Fundus photo · 1932x1932px · 45° field of view: 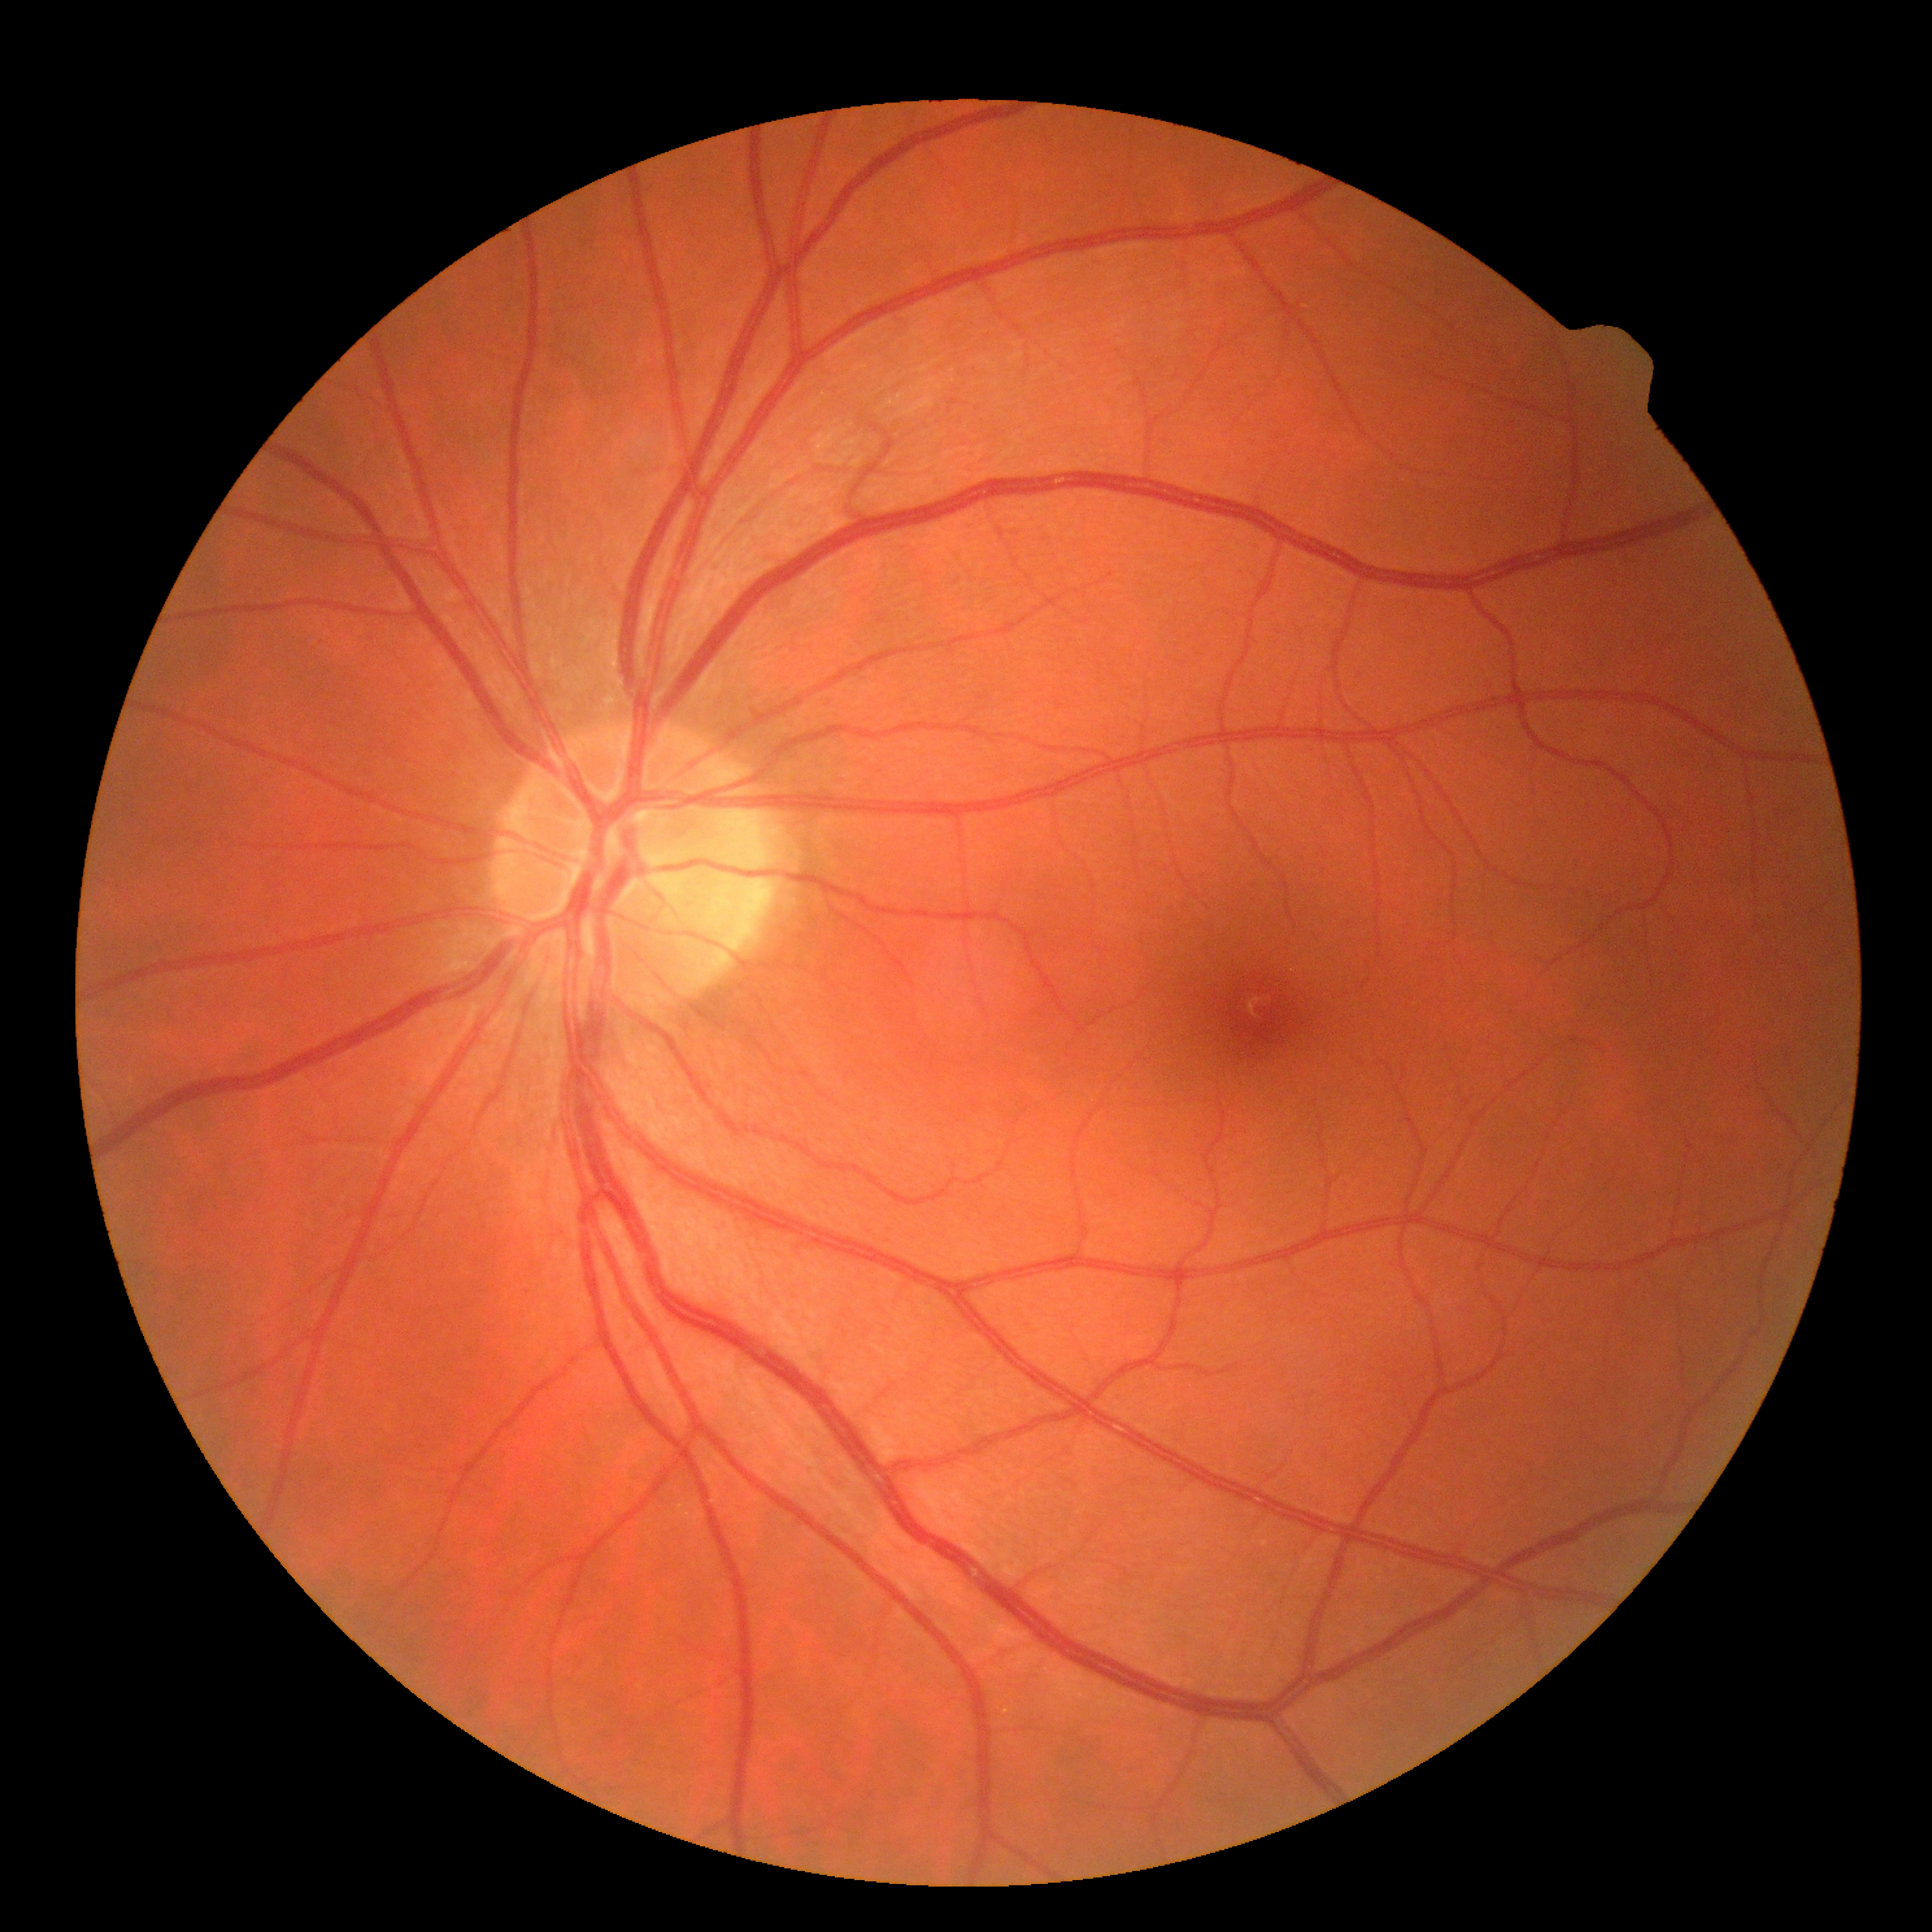
DR grade is no apparent retinopathy (0). No diabetic retinal disease findings.